Camera: NIDEK AFC-230; modified Davis classification; 45° FOV:
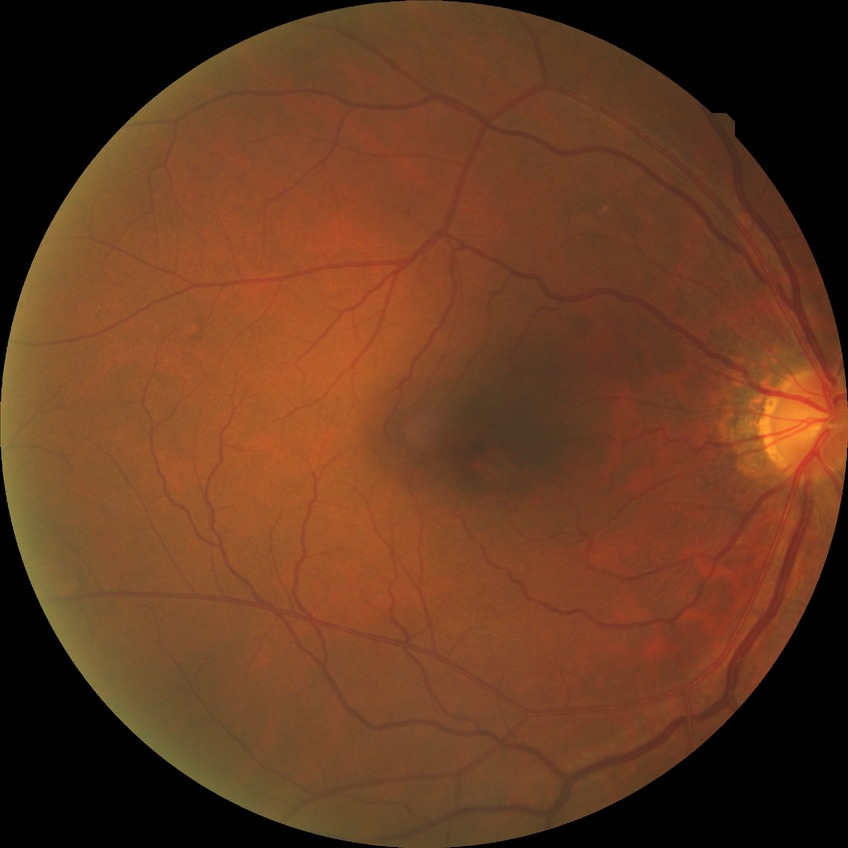 {
  "davis_grade": "no diabetic retinopathy"
}